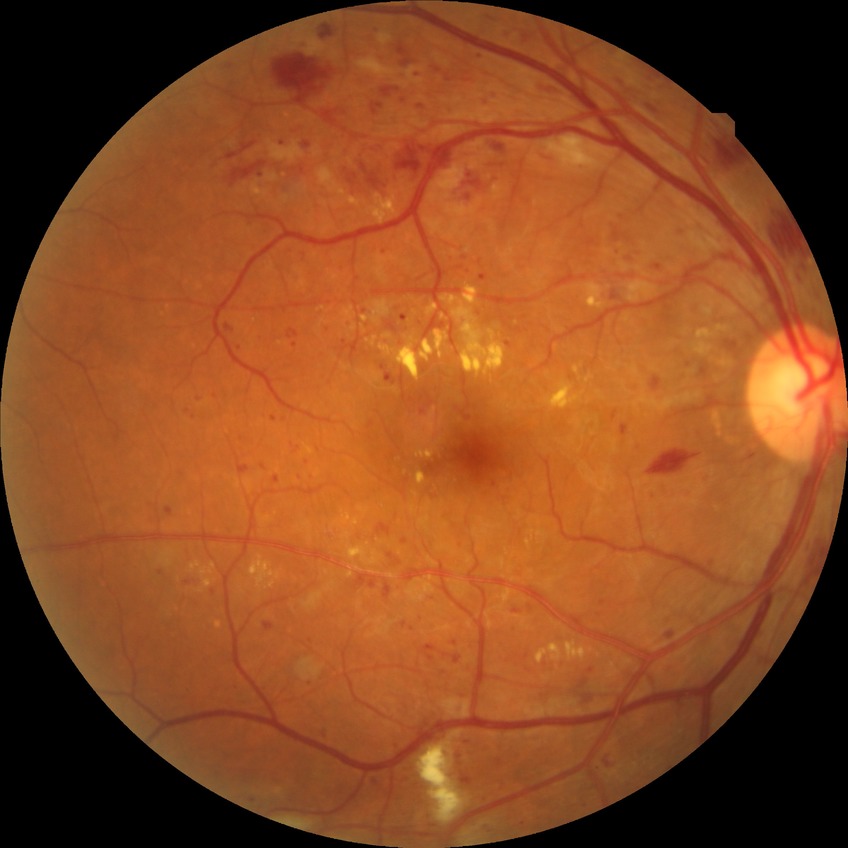 diabetic retinopathy (DR): PPDR (pre-proliferative diabetic retinopathy); DR class: non-proliferative diabetic retinopathy.